Camera: NIDEK AFC-230. 45° FOV. Nonmydriatic. 848 x 848 pixels. Posterior pole color fundus photograph: 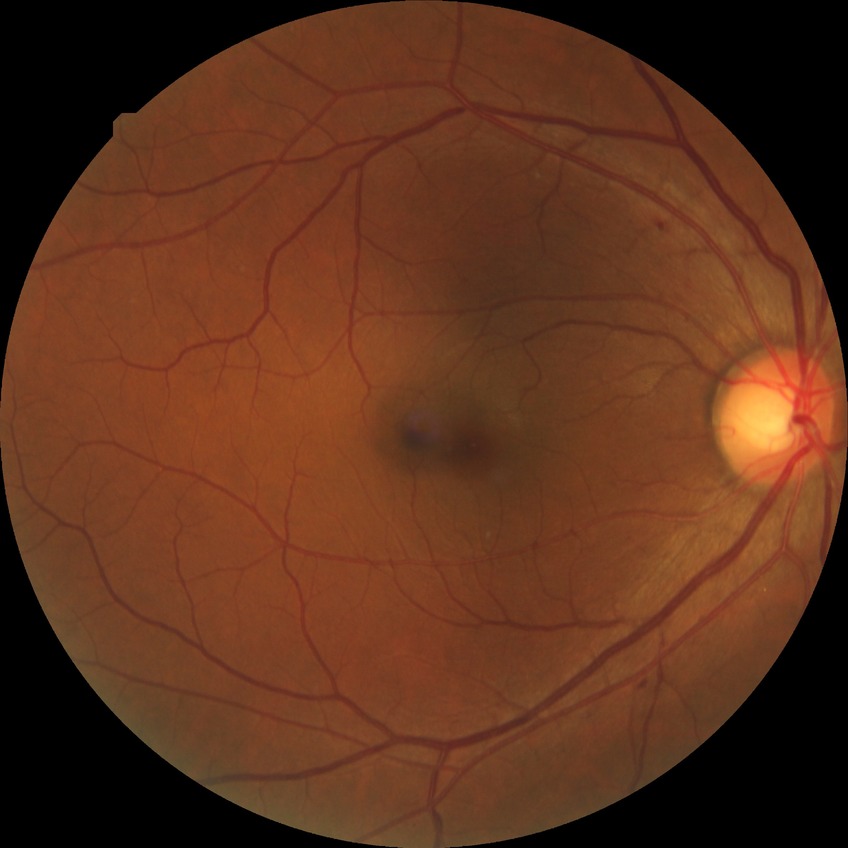 Annotations:
- diabetic retinopathy stage — simple diabetic retinopathy
- DR class — non-proliferative diabetic retinopathy